Infant wide-field retinal image:
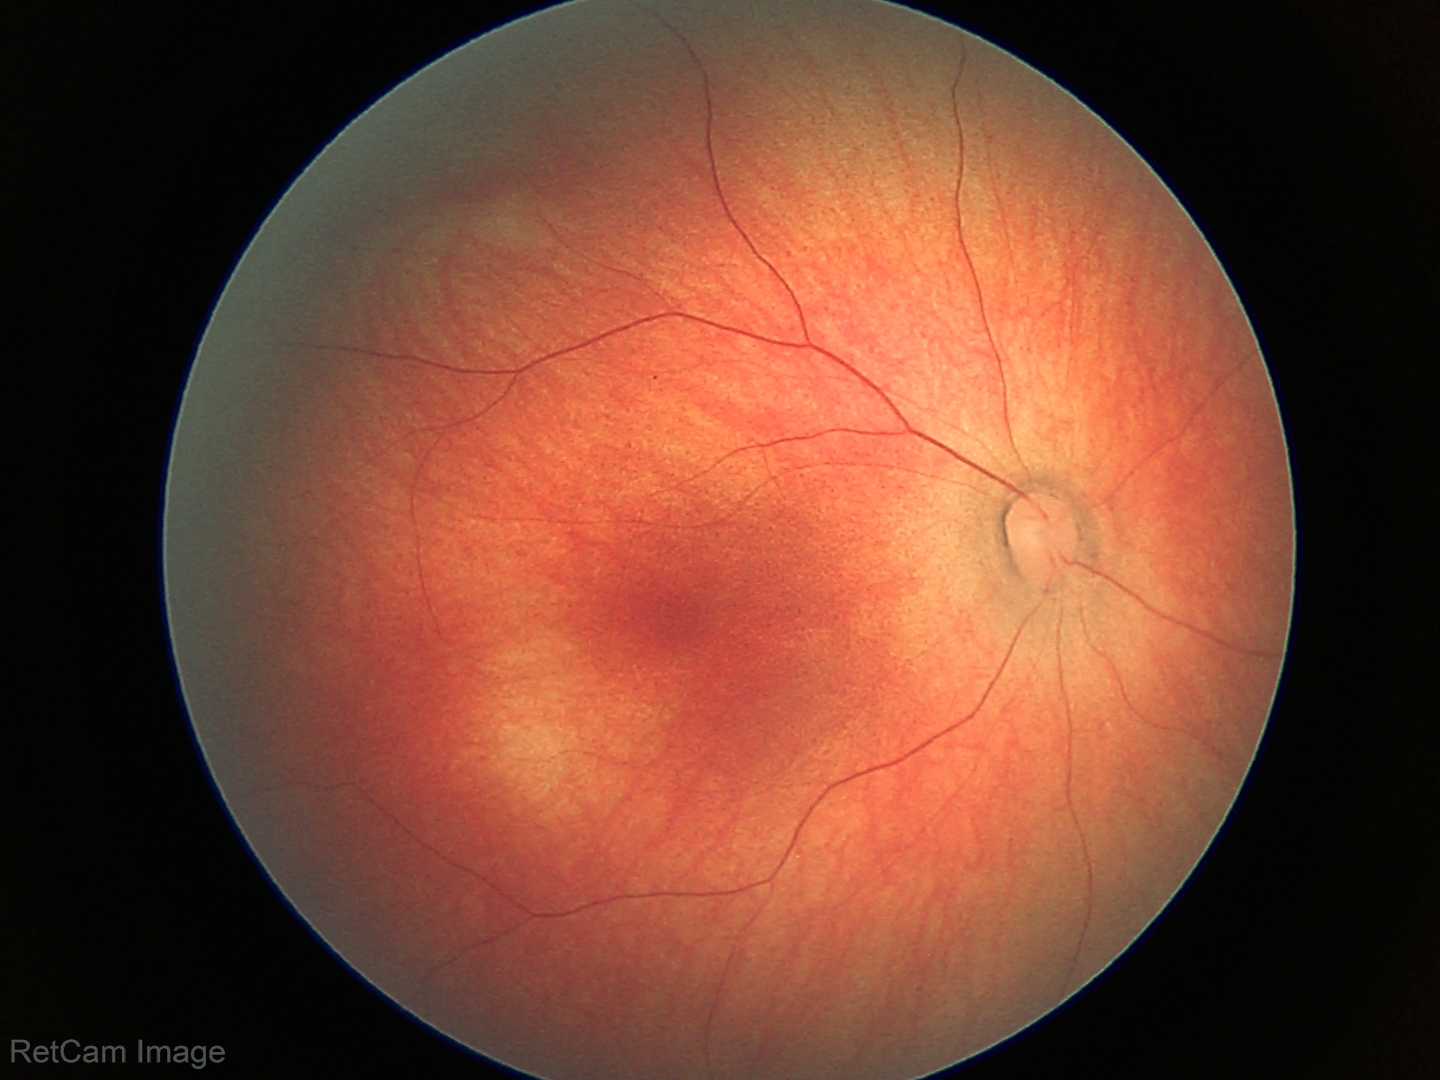
Examination with physiological retinal findings.